RetCam wide-field infant fundus image: 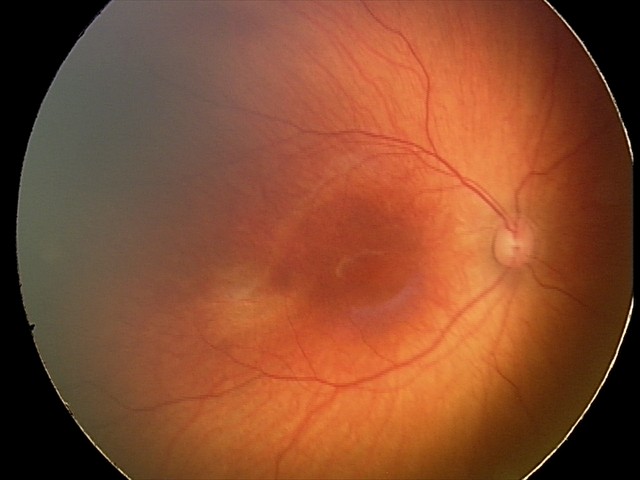

Assessment: no abnormalities.